45° FOV. NIDEK AFC-230 fundus camera. Without pupil dilation
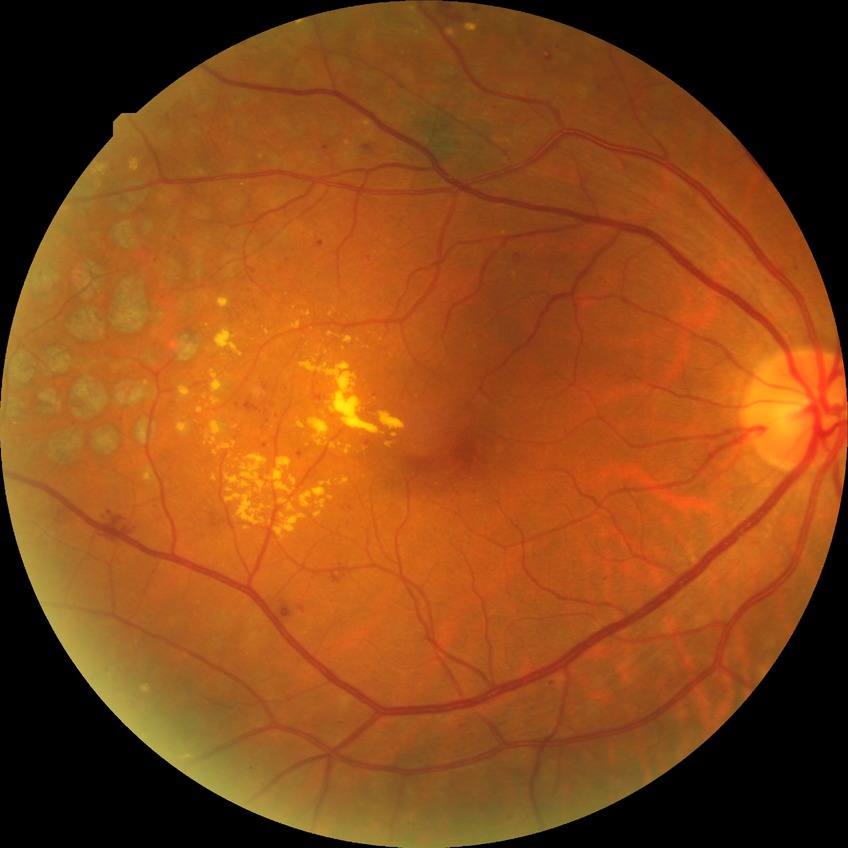 diabetic retinopathy (DR): proliferative diabetic retinopathy (PDR).